45° FOV. CFP — 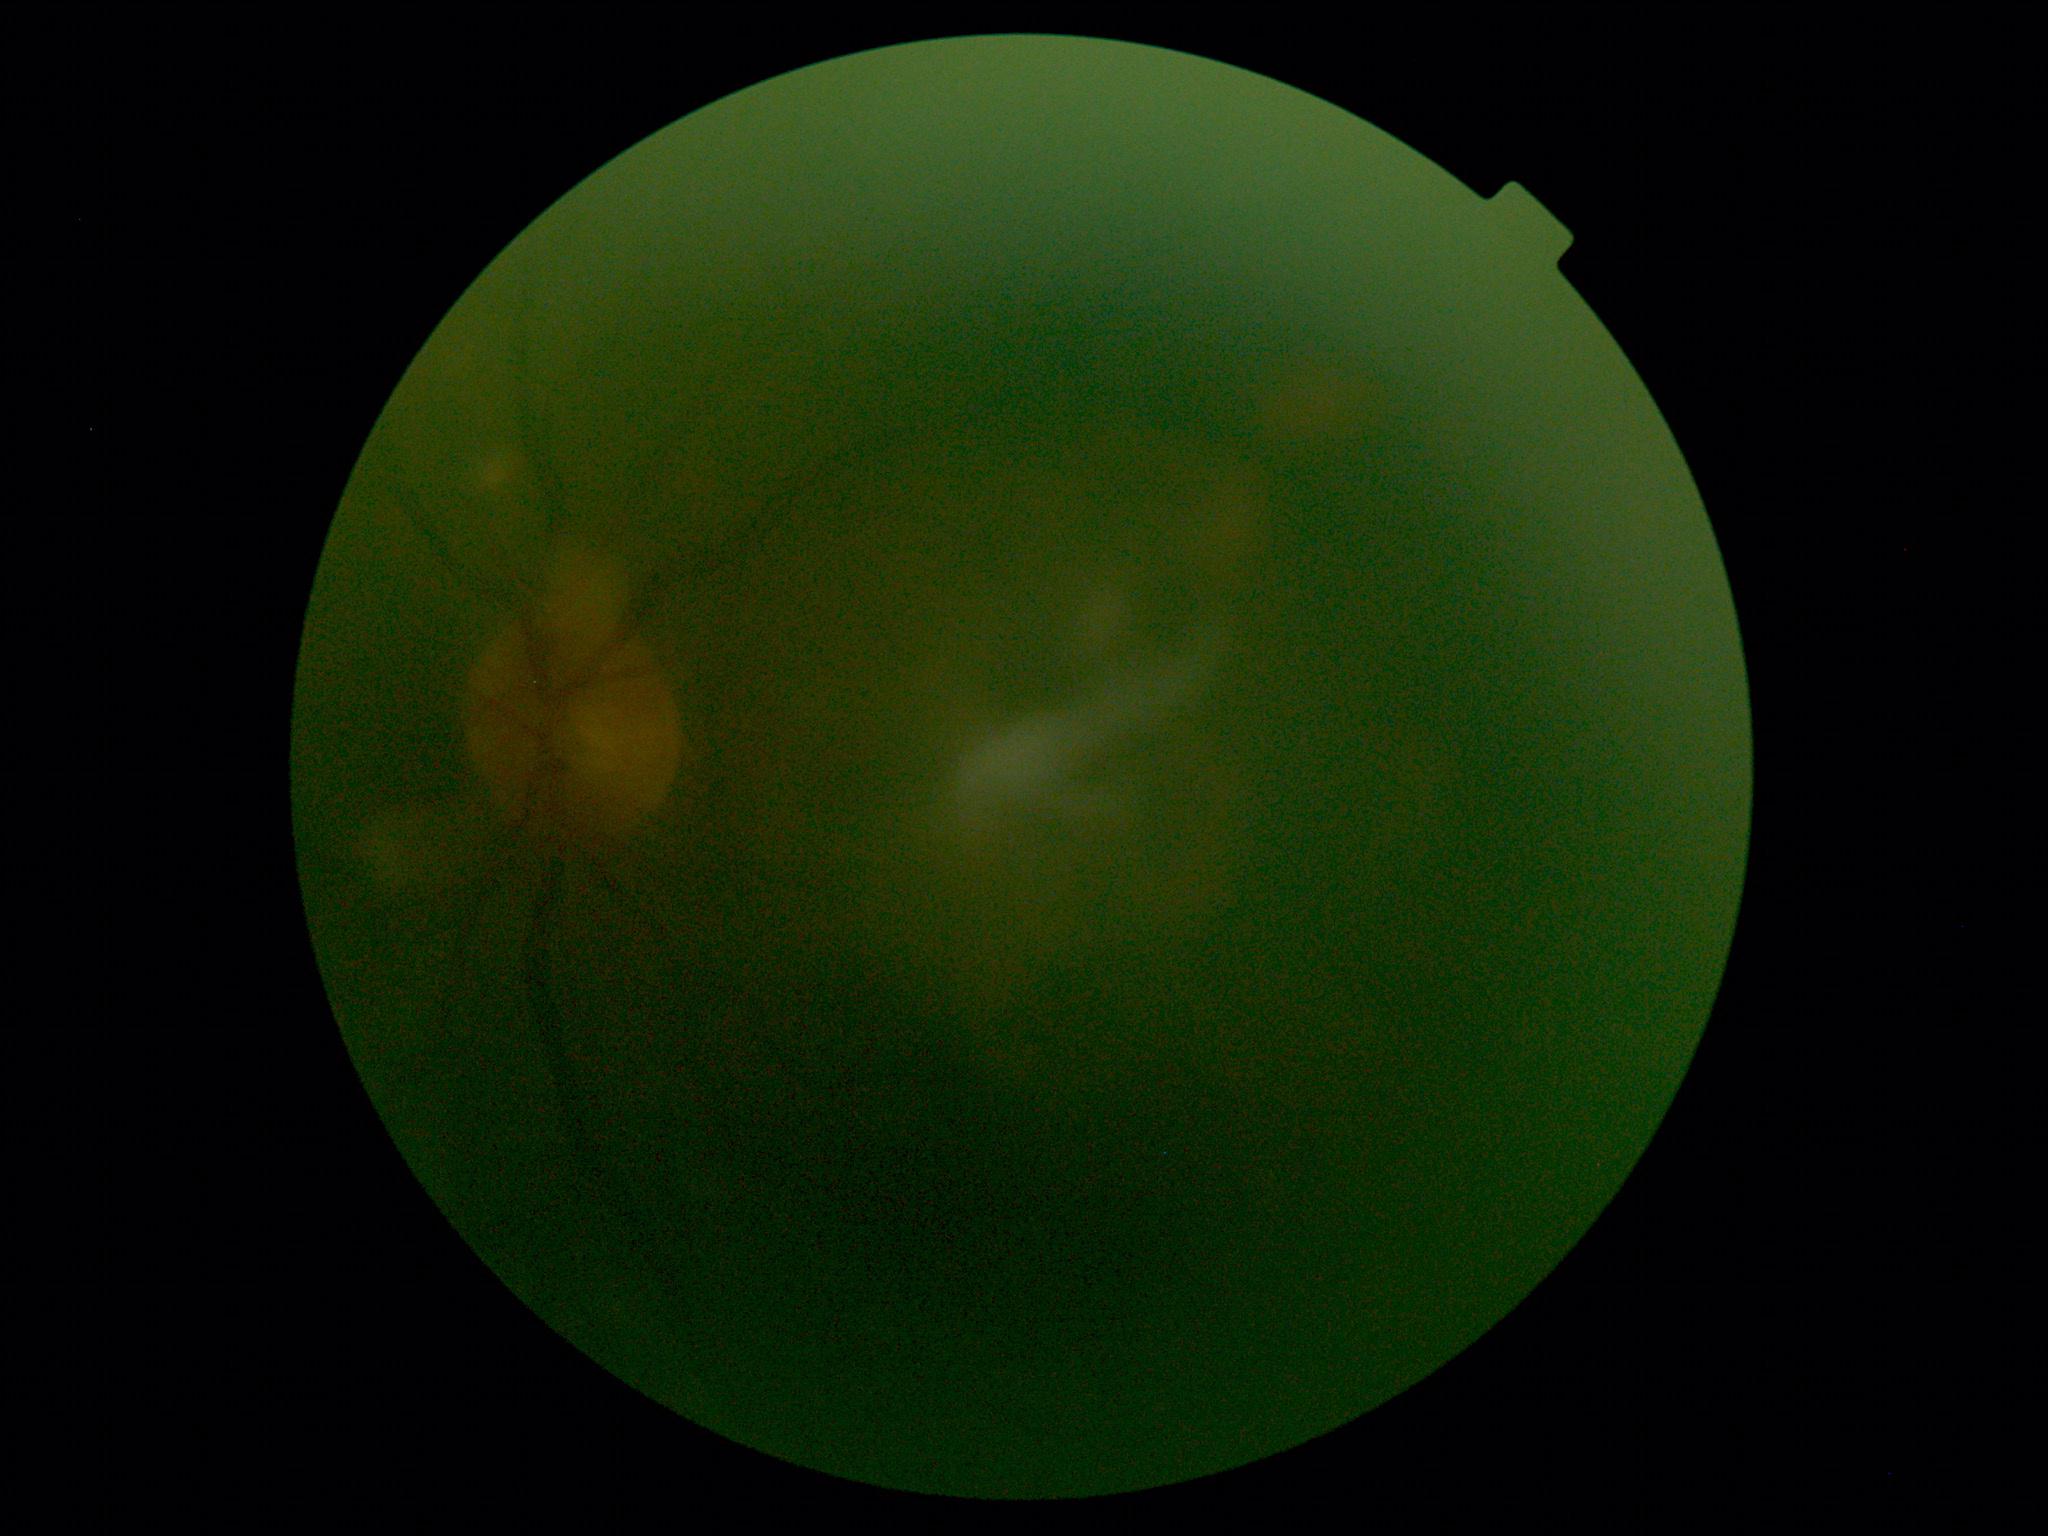
Retinopathy grade: ungradable.
Quality too poor to assess for DR.